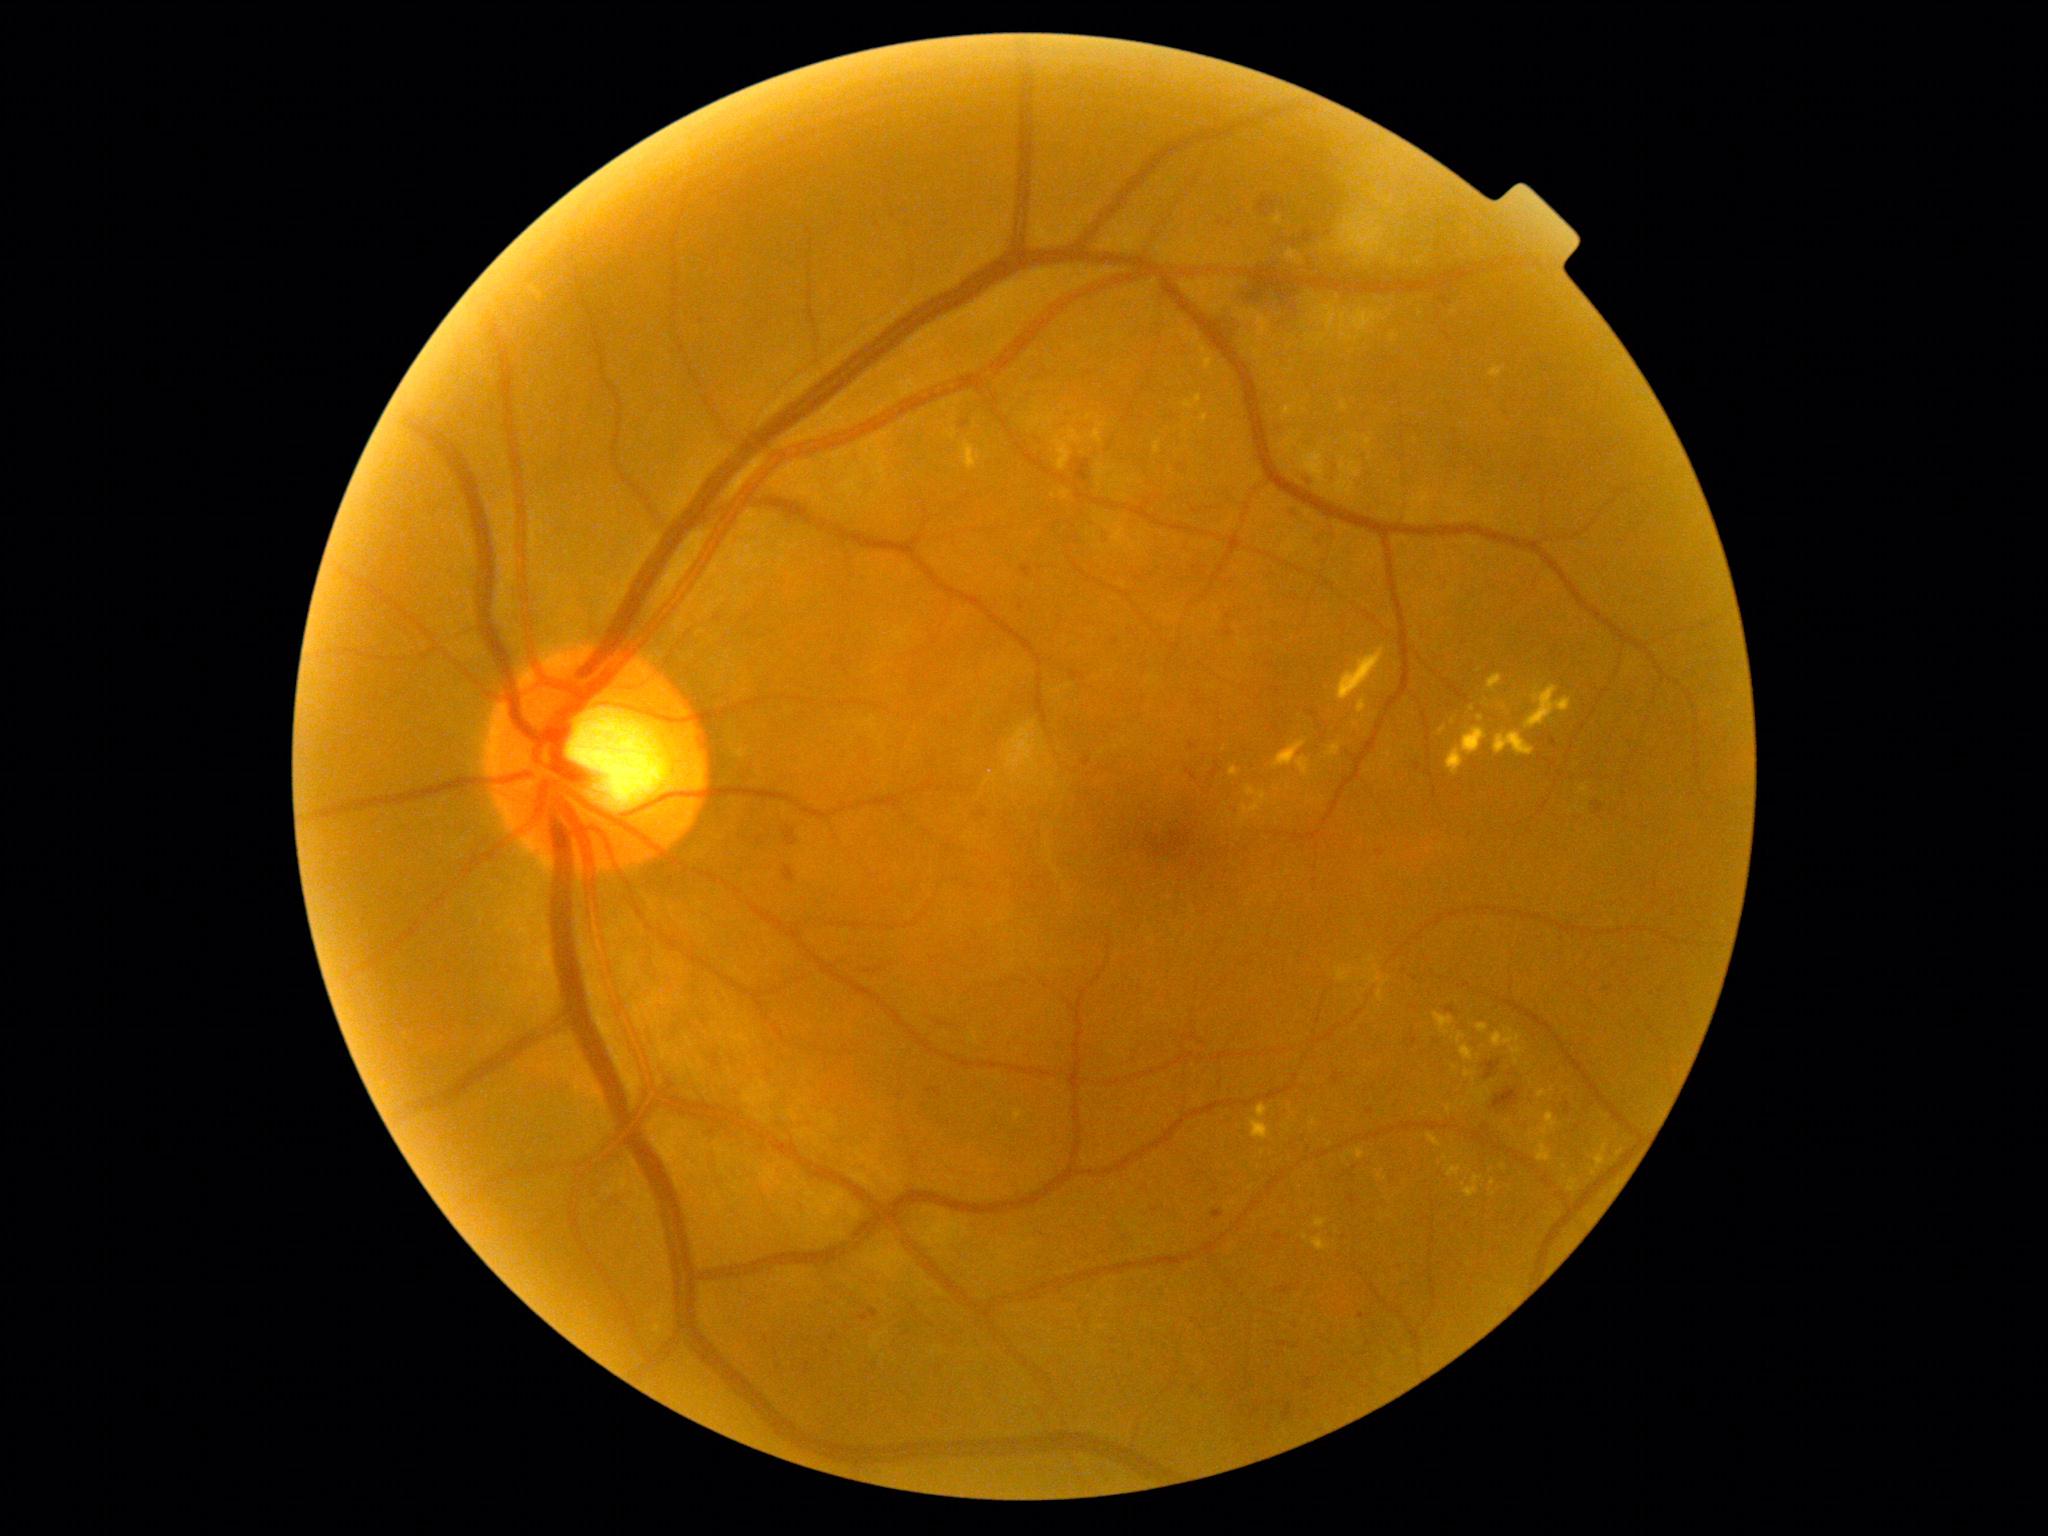
{"partial":true,"dr_grade":2,"lesions":{"ex":[[1314,1217,1329,1229],[1273,740,1310,776],[1511,1045,1525,1065],[1389,332,1400,341],[1462,1176,1484,1197],[1568,1178,1578,1193],[1446,1104,1452,1114],[1327,743,1342,758],[1249,1104,1271,1141],[1476,1024,1489,1034],[1154,441,1163,454]],"ex_small":[[1488,1090],[1533,1141],[1594,1173],[1564,1166],[1492,1193]]}}